2352x1568.
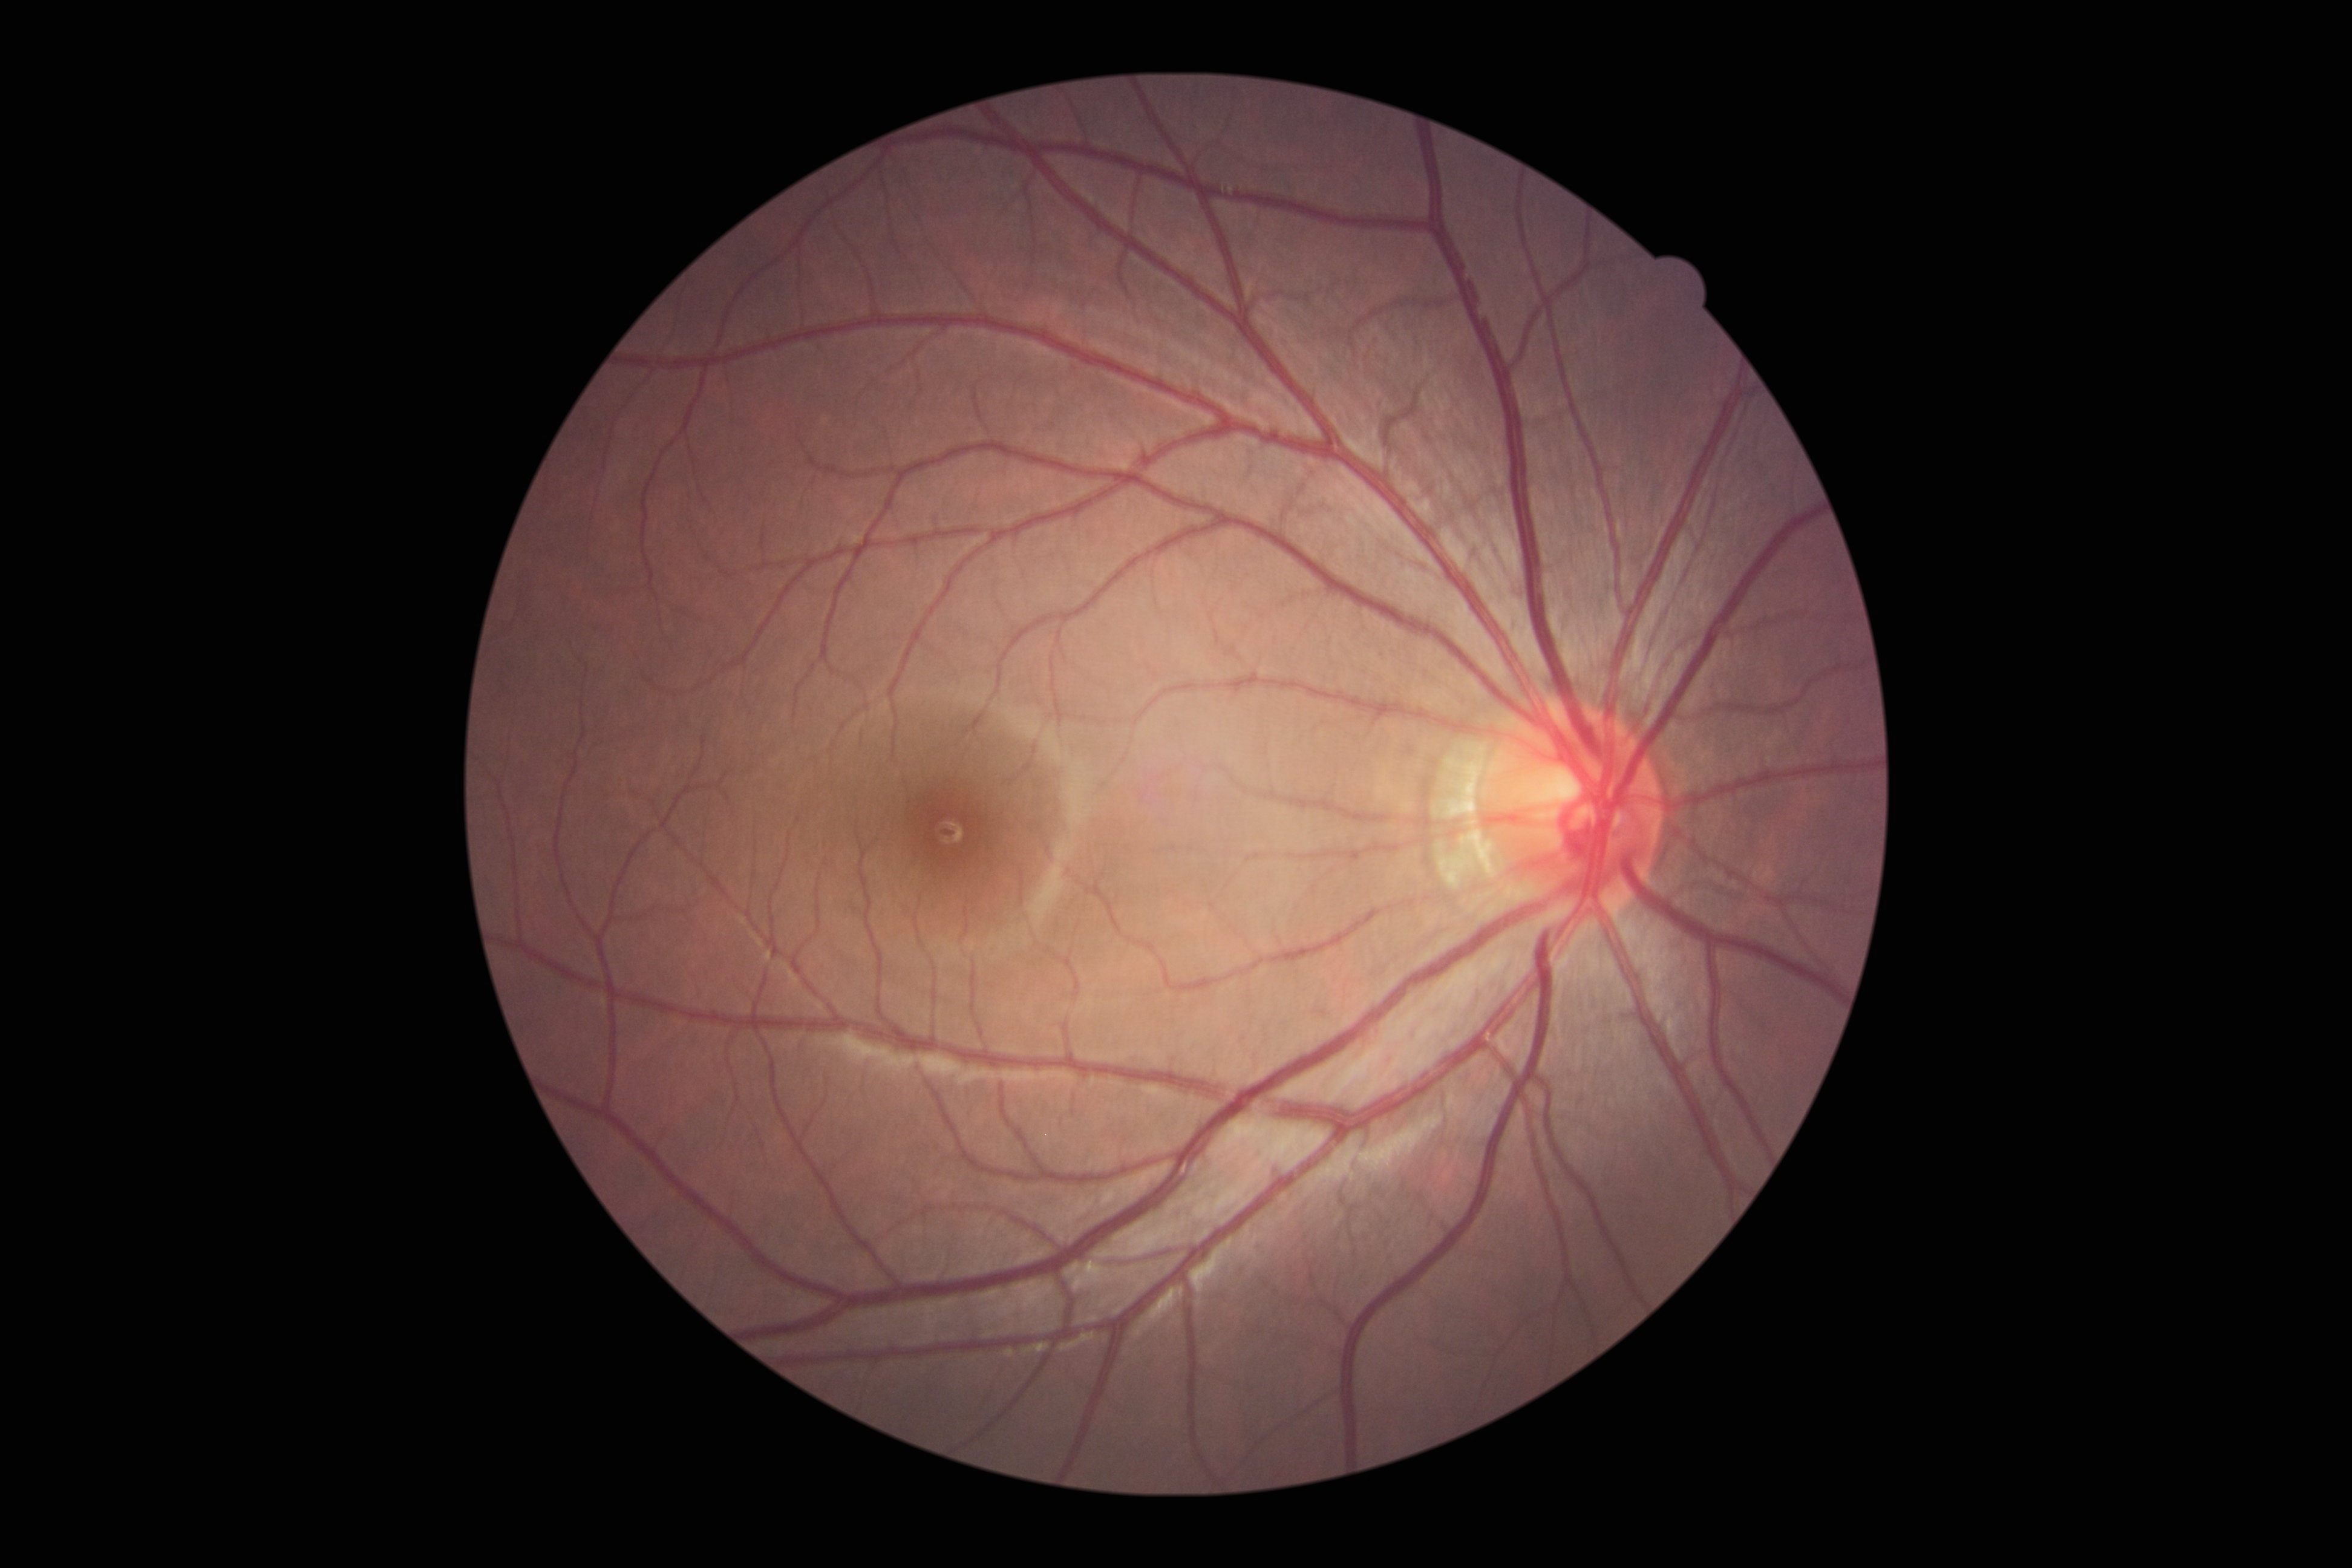

DR: 0. No apparent diabetic retinopathy.